RetCam wide-field infant fundus image. Image size 1440x1080 — 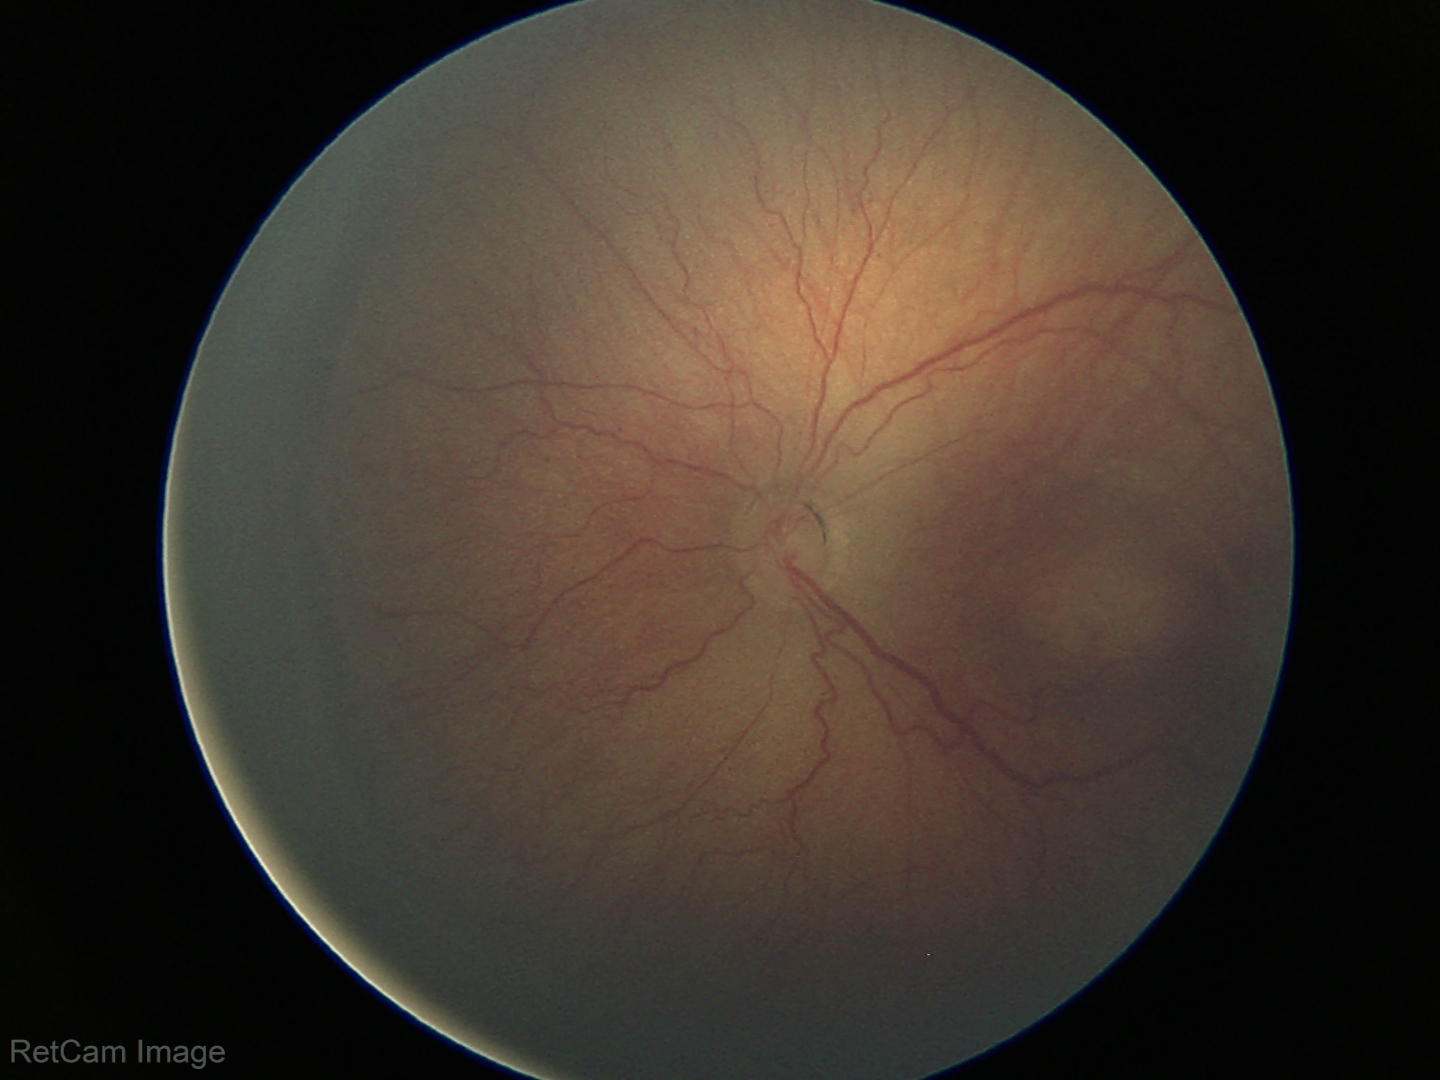
Plus disease = absent — posterior pole vessels without abnormal dilation or tortuosity; impression = retinopathy of prematurity stage 3.